Pediatric wide-field fundus photograph:
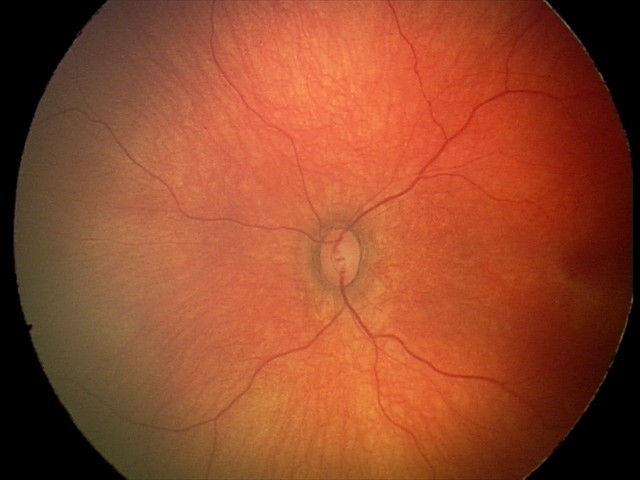

Q: What is the diagnosis from this examination?
A: no abnormal retinal findings